1932 by 1932 pixels · dilated-pupil acquisition
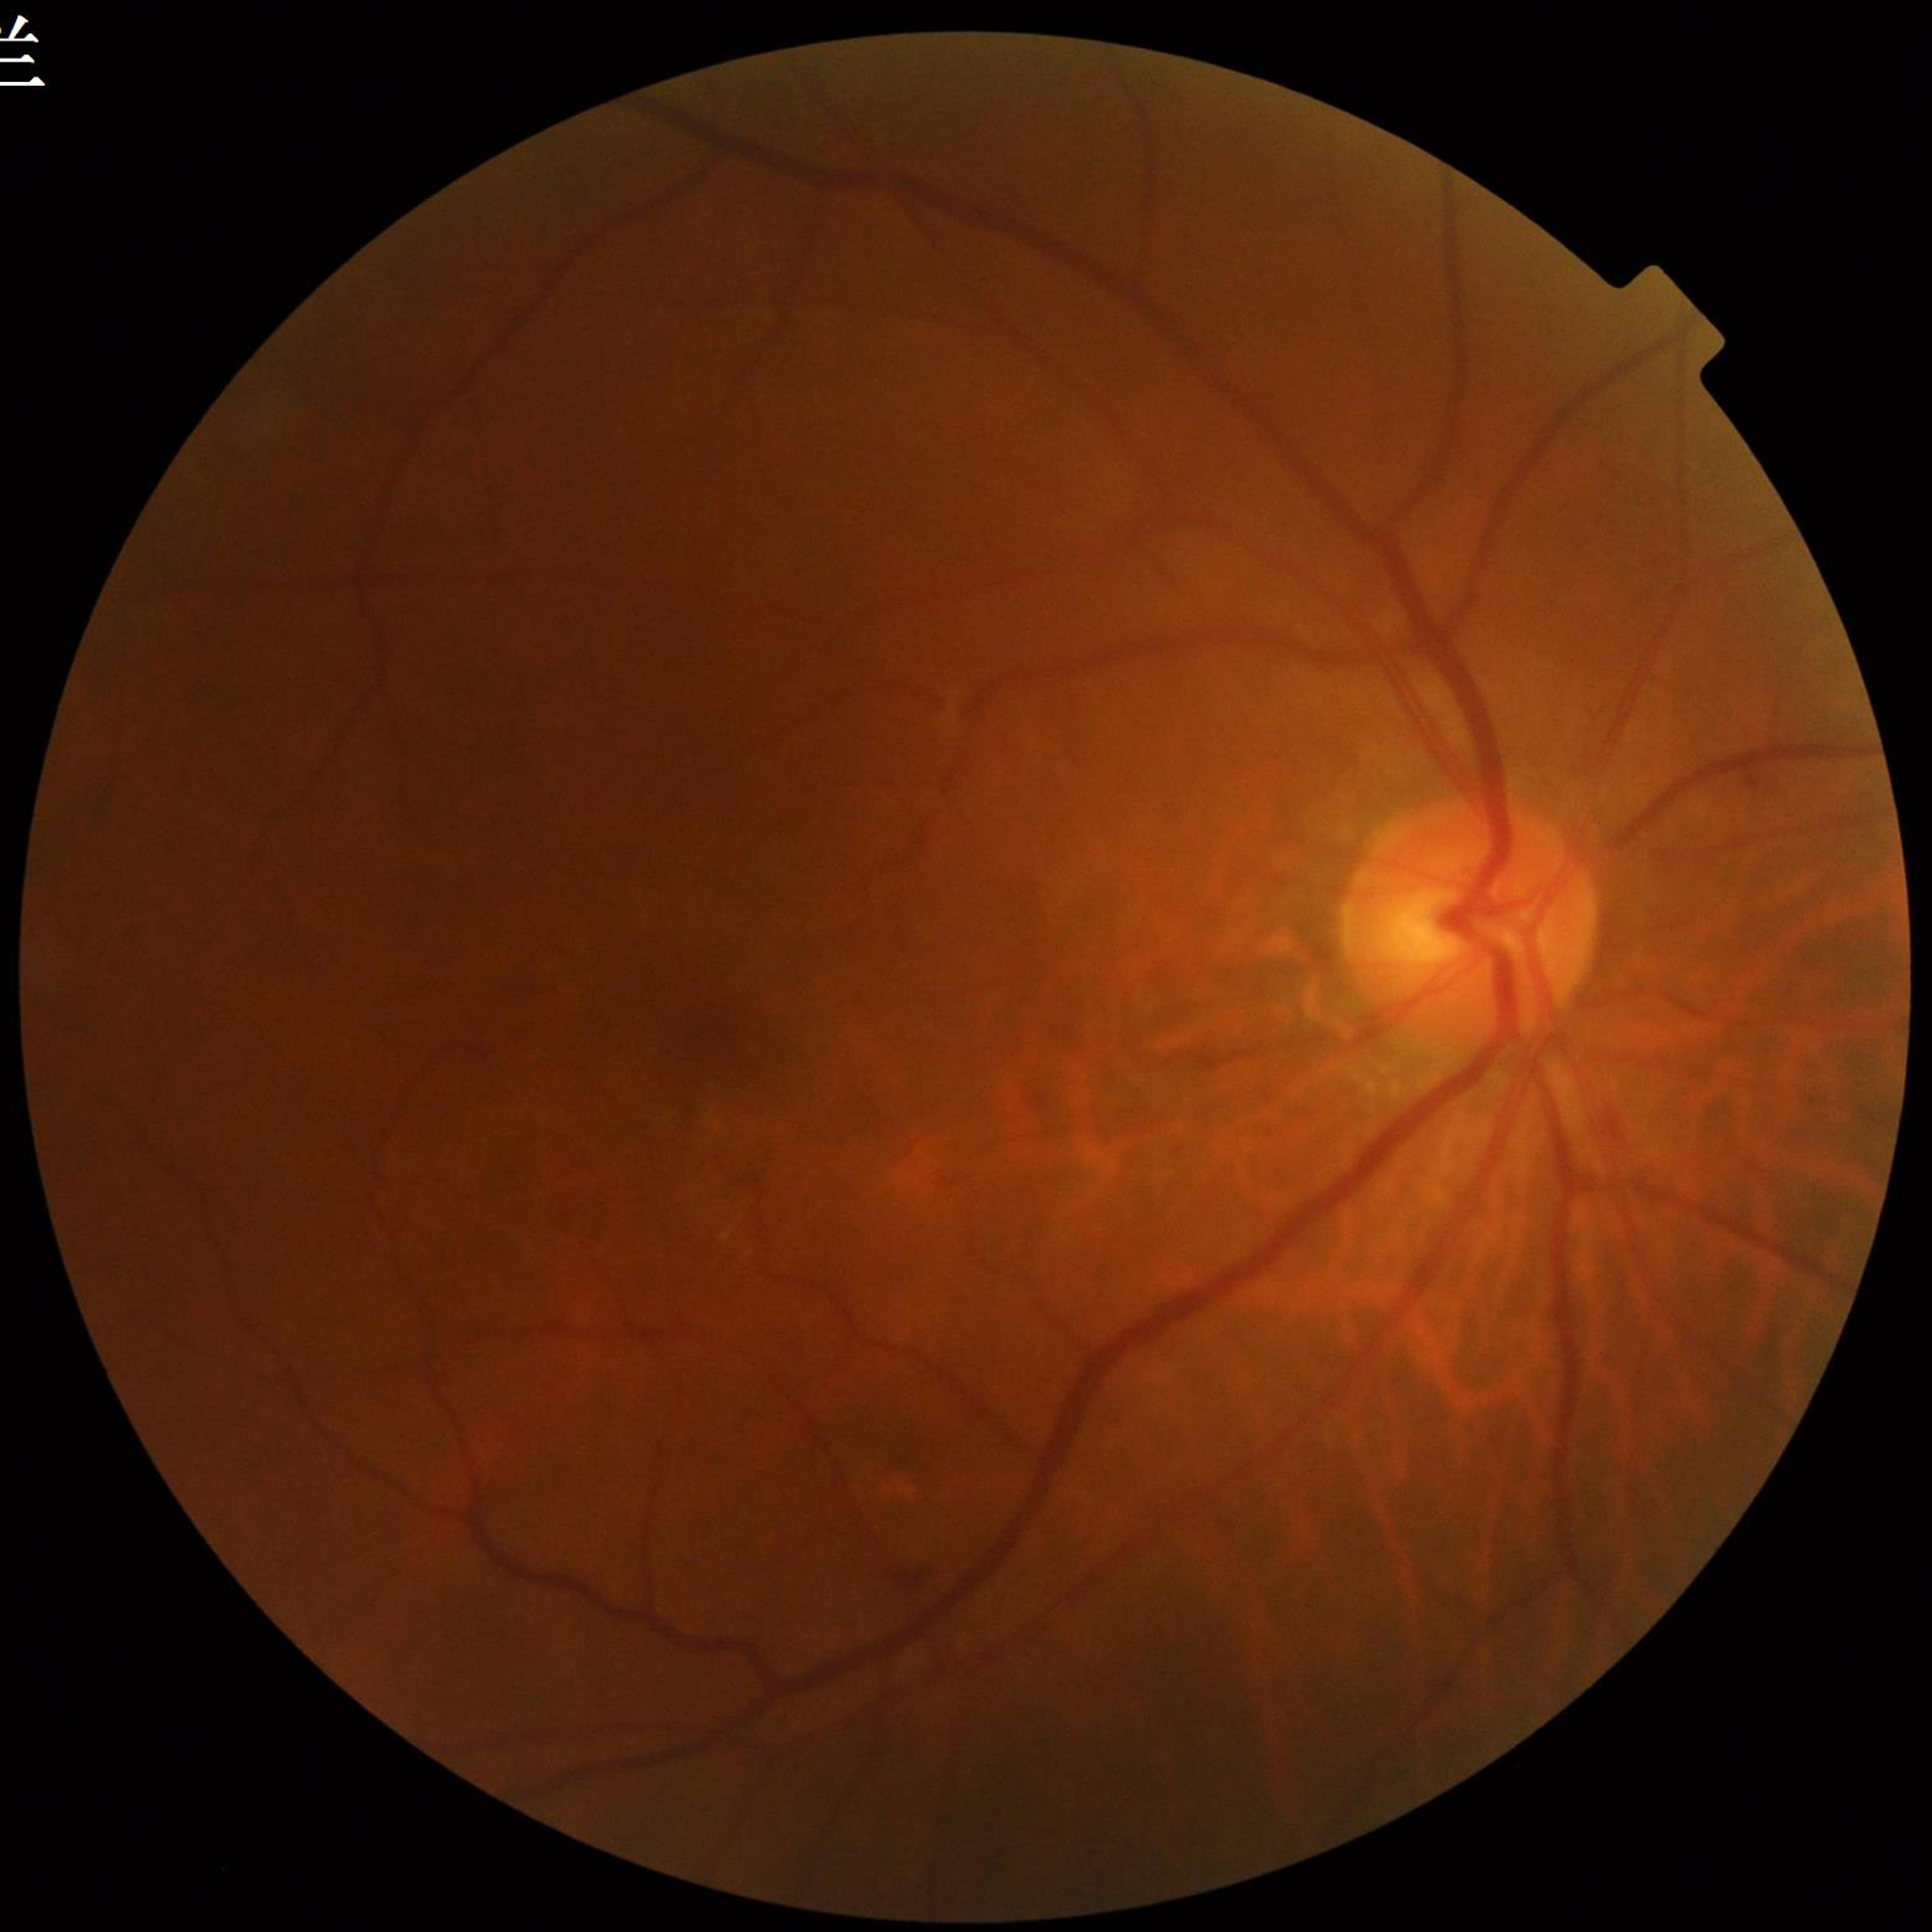 Disease class: DR.